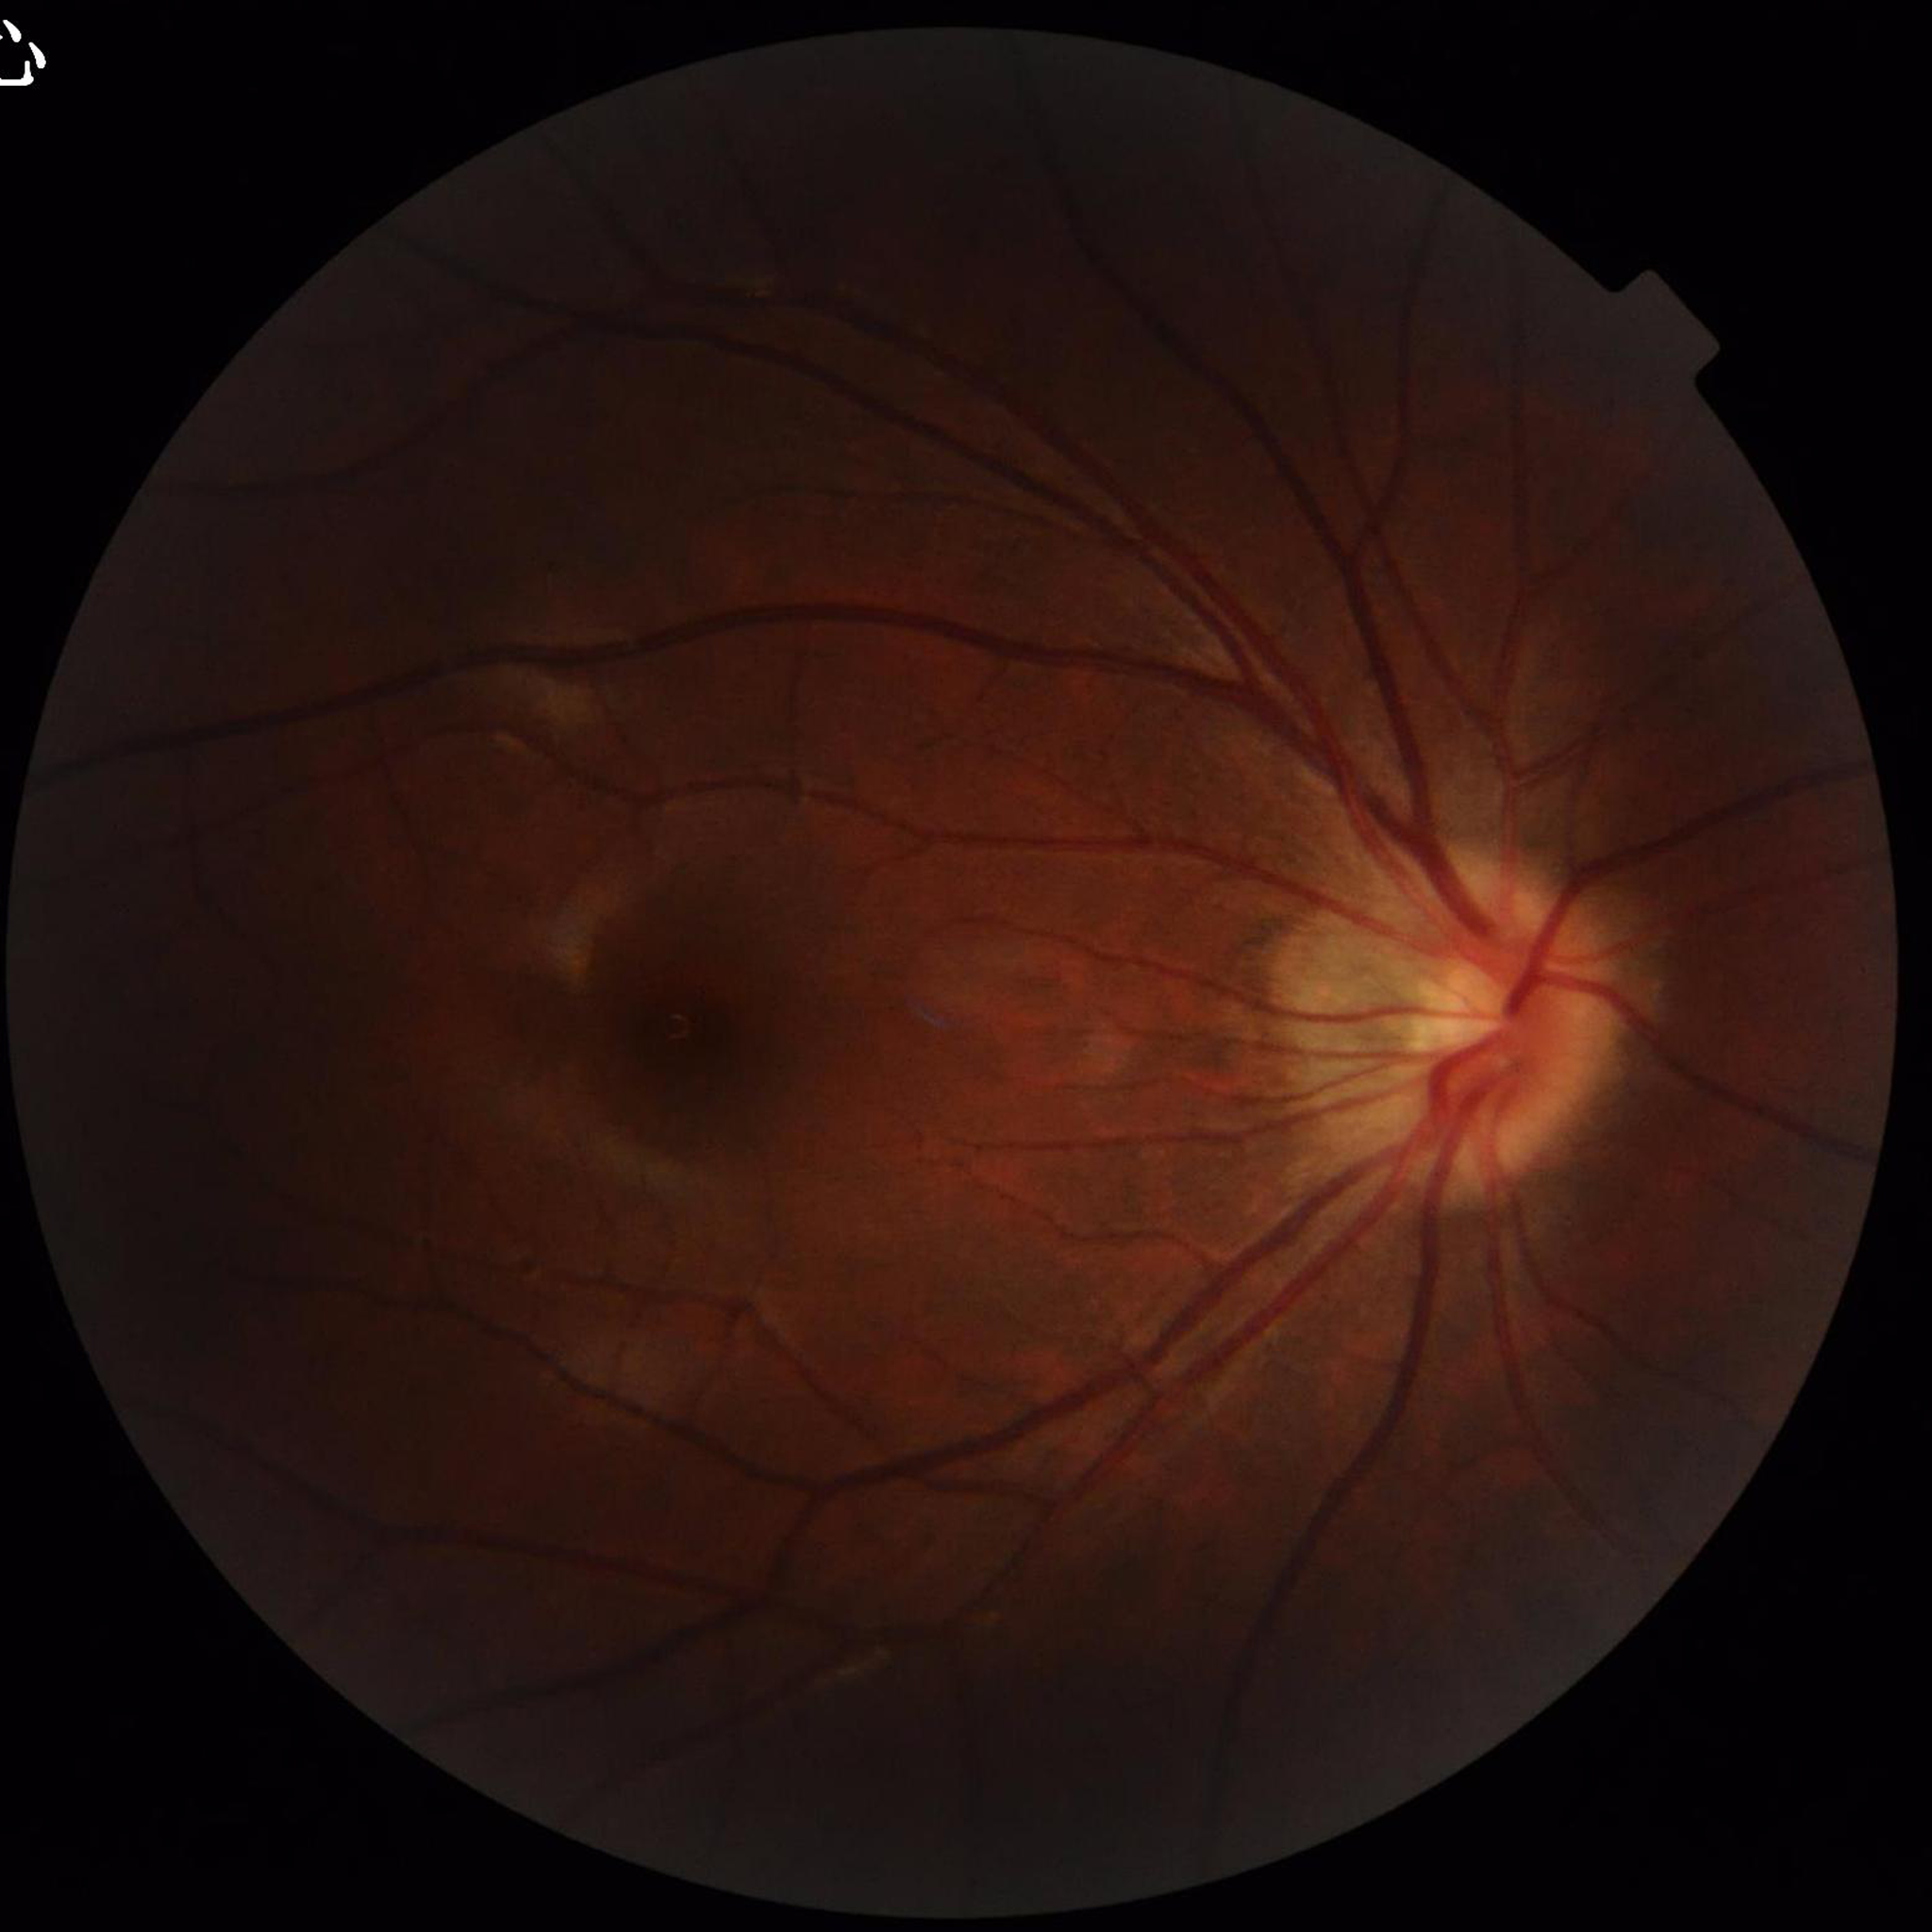

Condition: no AMD, DR, or glaucoma | Image quality: contrast adequate, illumination/color distortion present, no blur.